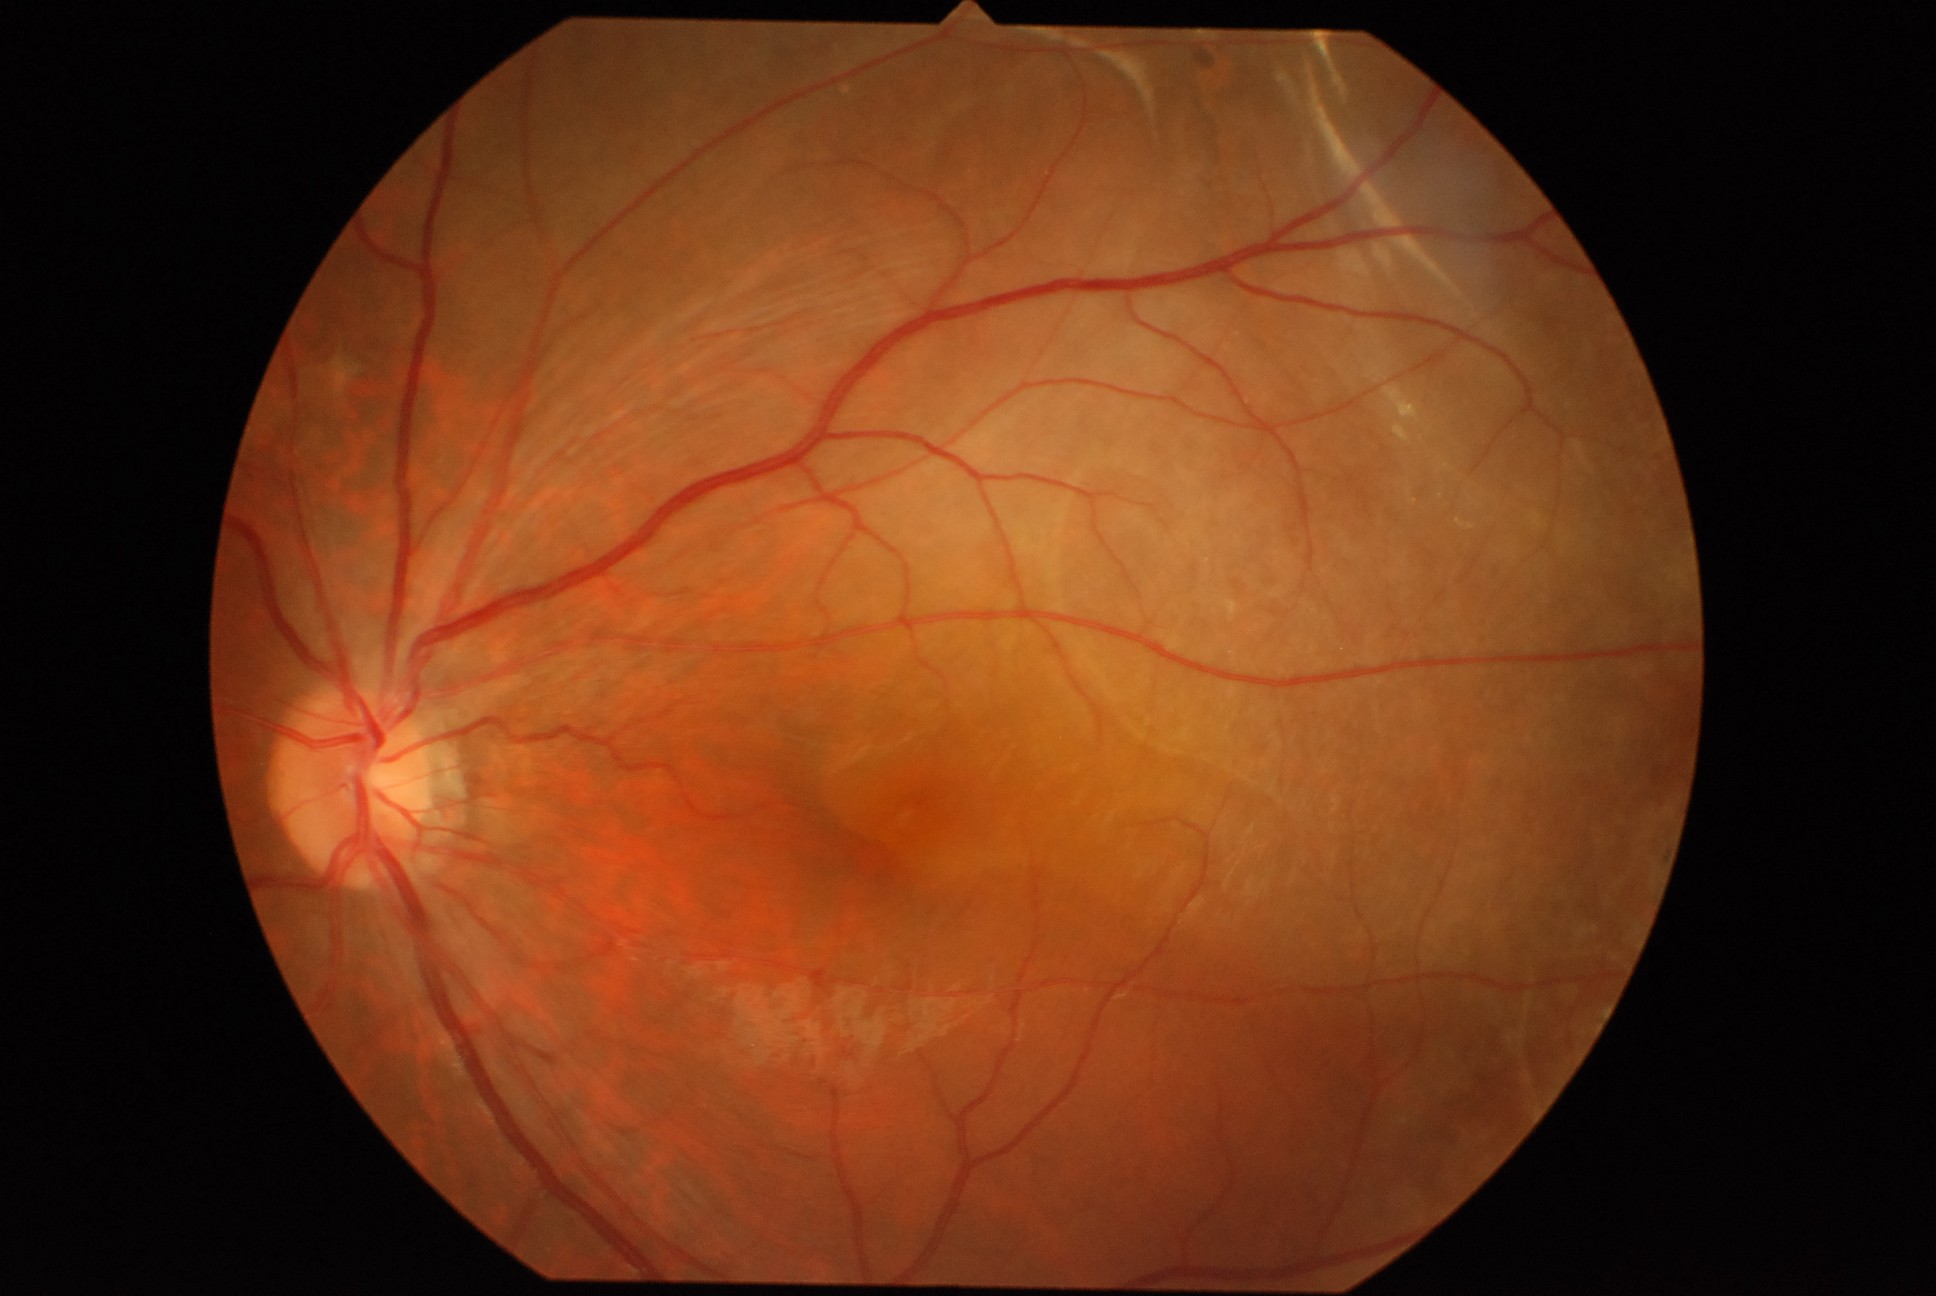

dr_grade: 4/4